Posterior pole photograph; acquired with a NIDEK AFC-230; Davis DR grading — 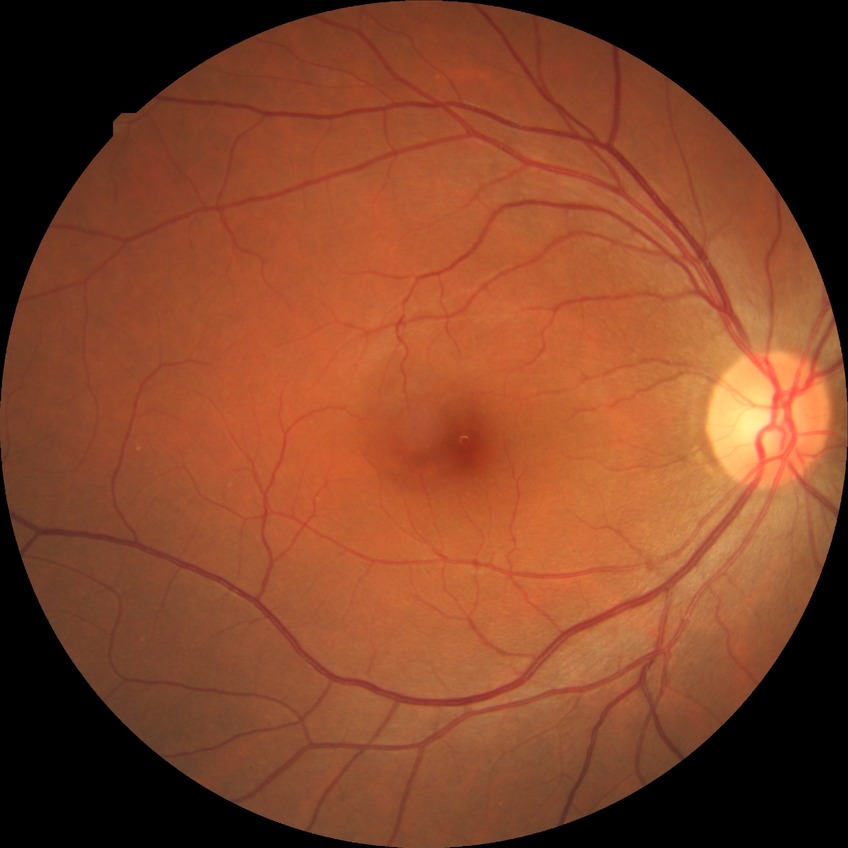 Annotations:
* diabetic retinopathy (DR): no diabetic retinopathy (NDR)